Fundus photo · acquired with a NIDEK AFC-230 · Davis DR grading — 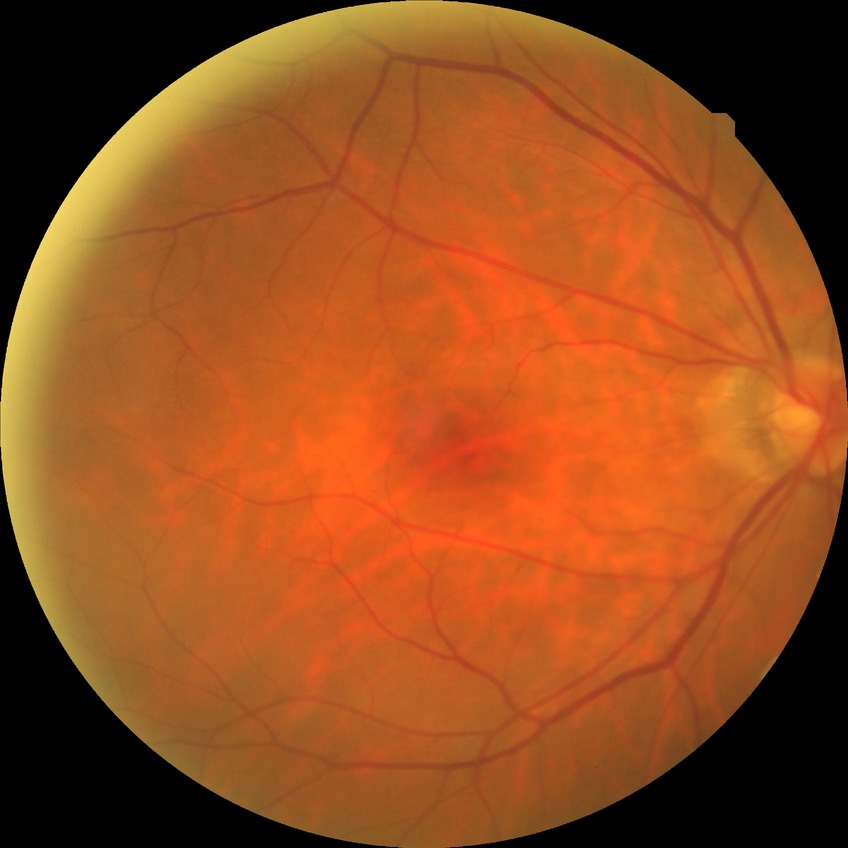
Davis grade: NDR.